2184 x 1690 pixels · CFP · 45-degree field of view.
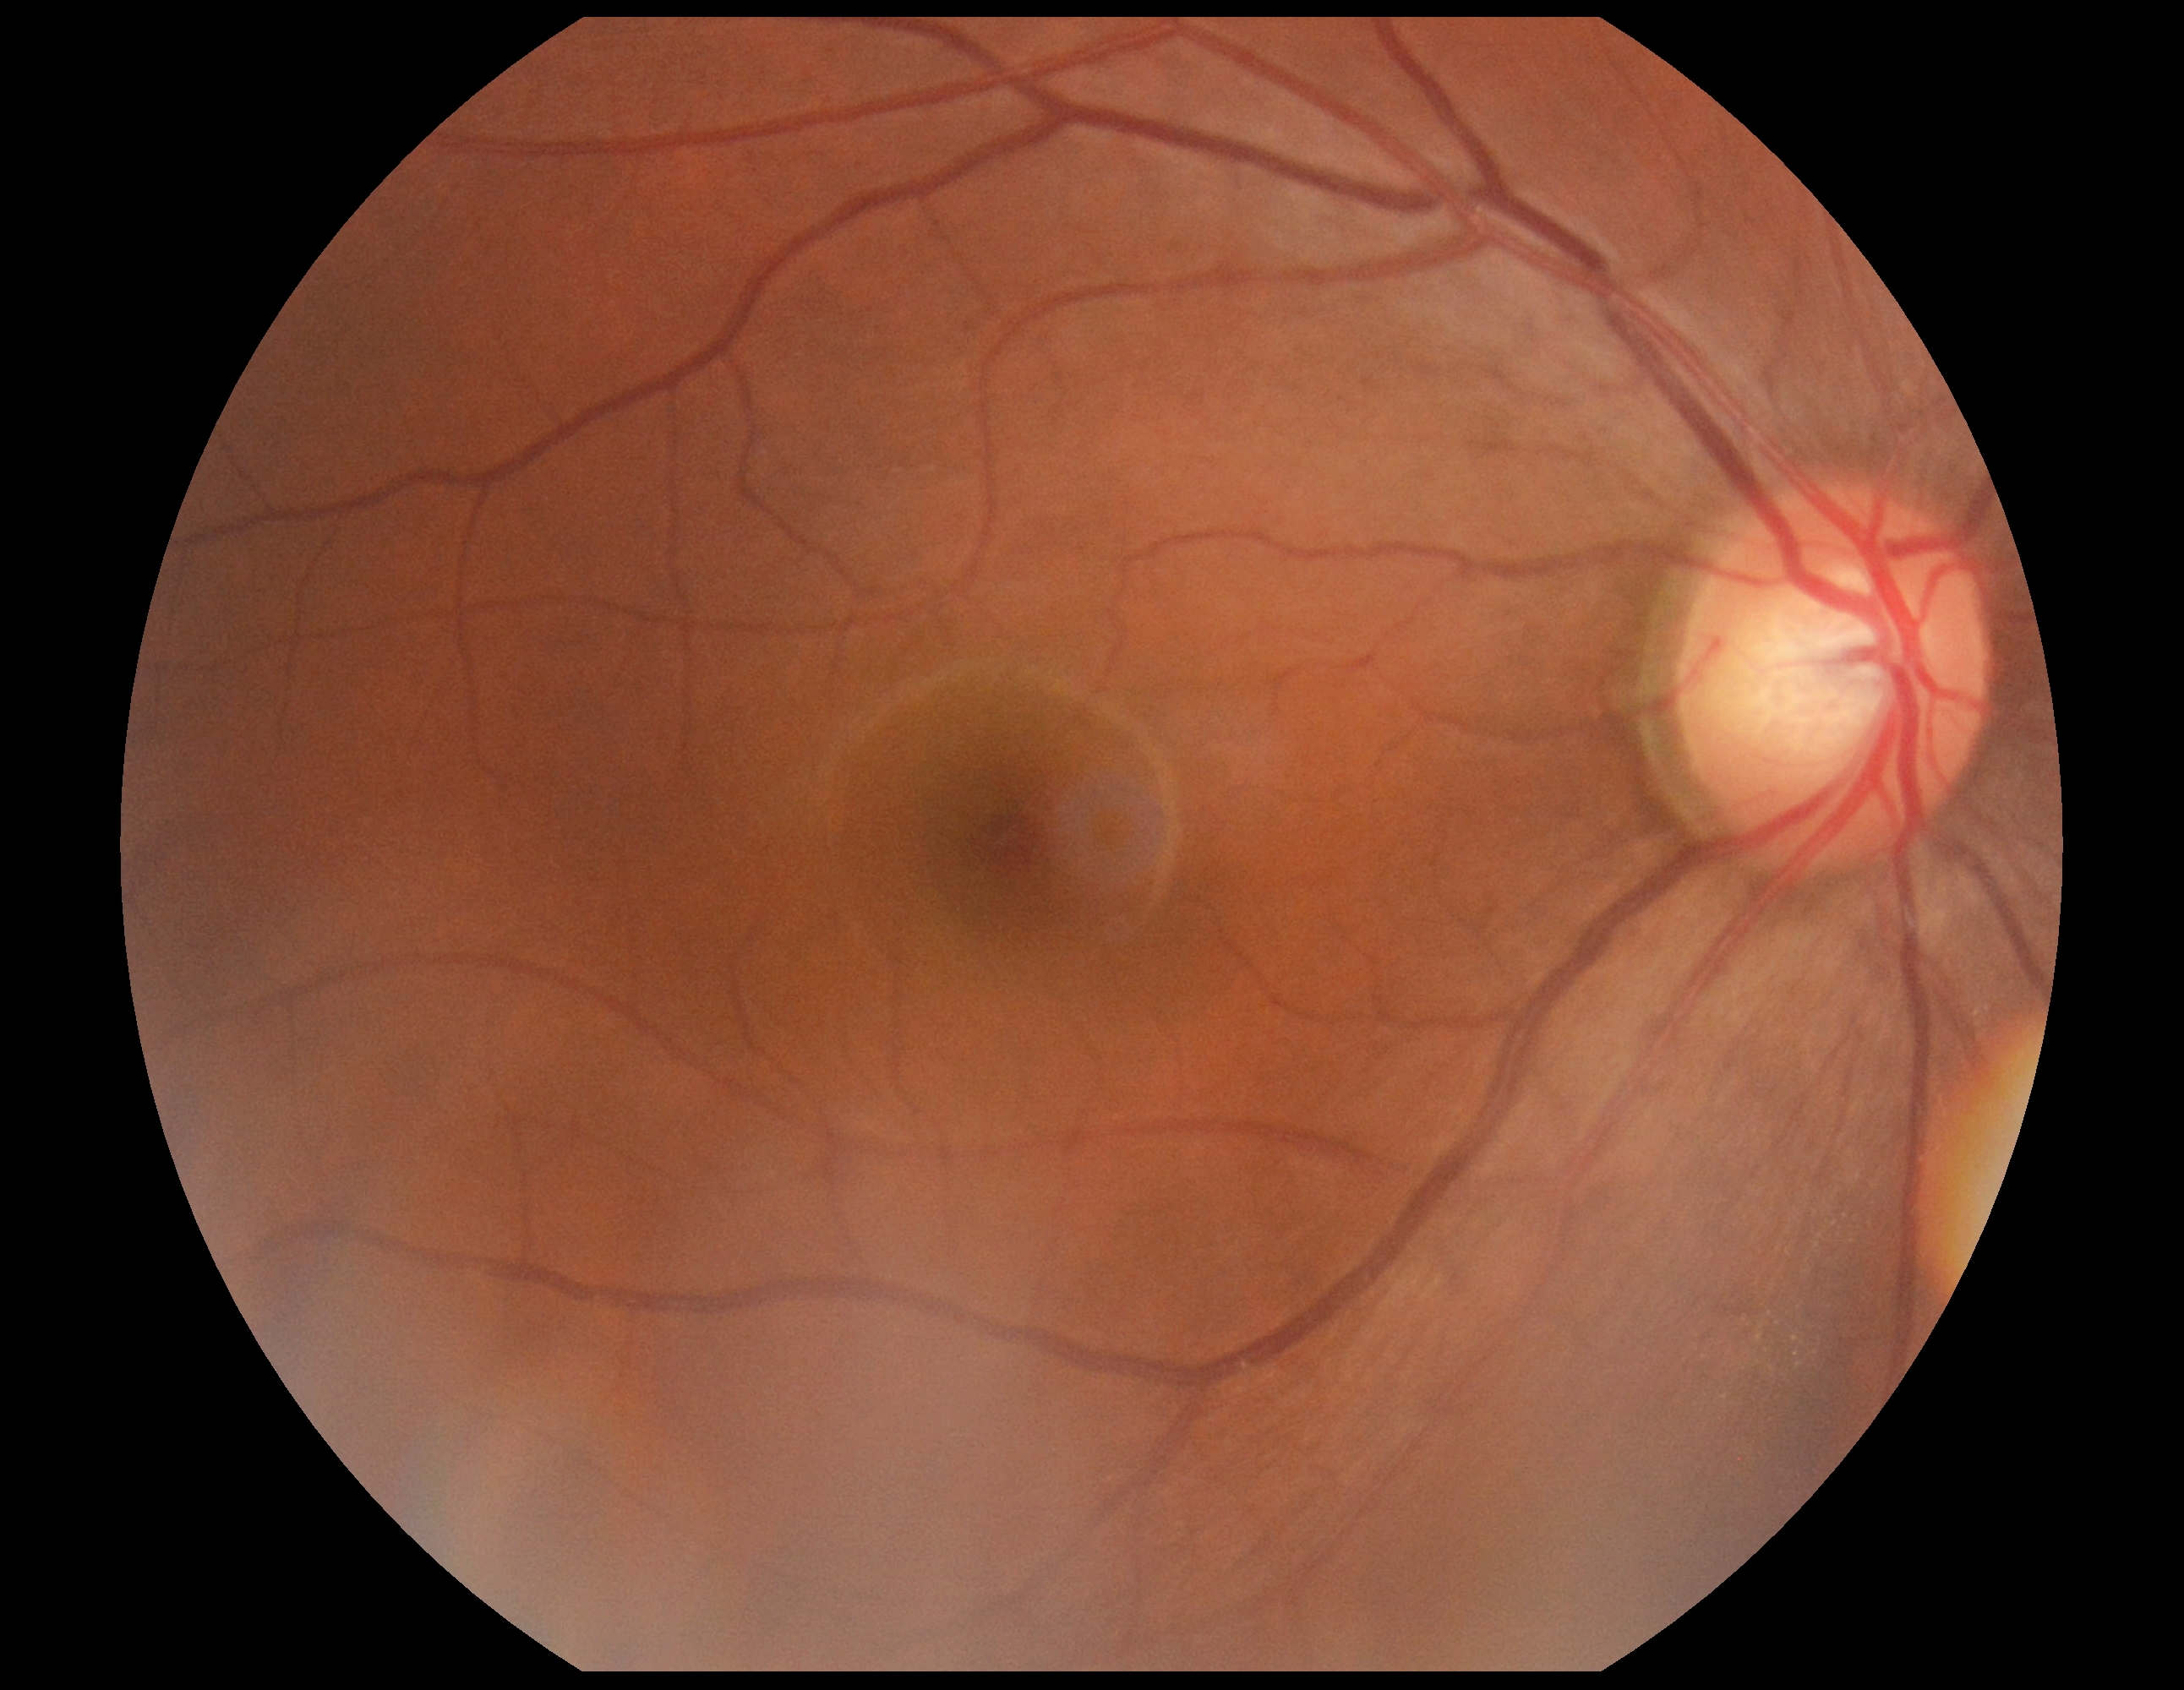

DR severity: 0/4.